Color fundus image.
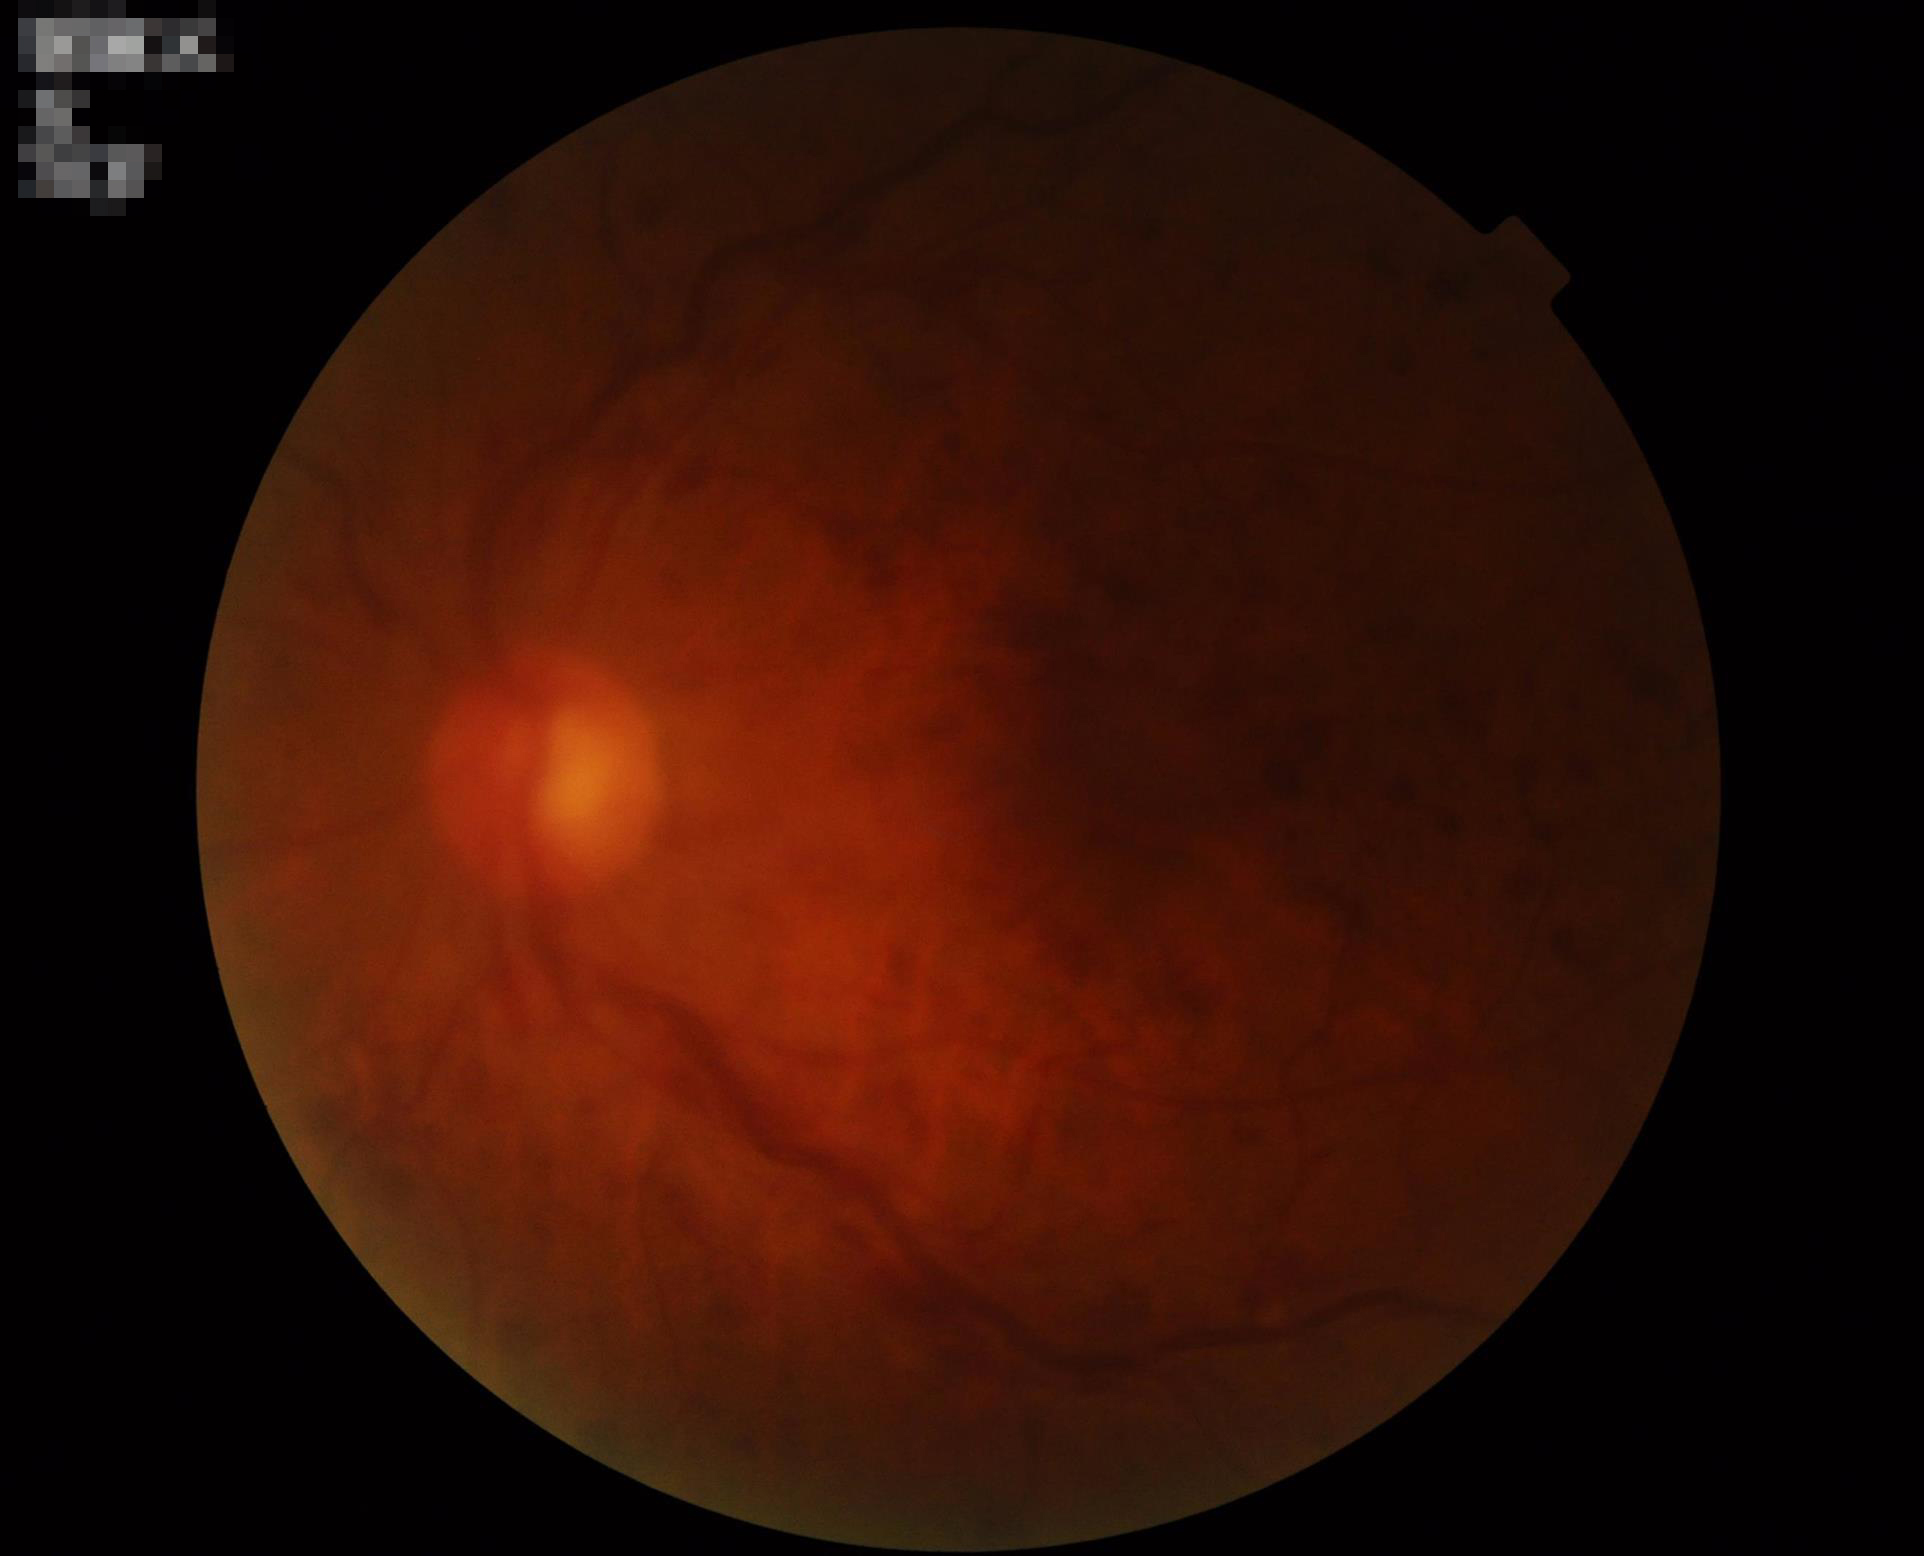

Quality grading: illumination: uneven illumination or color cast | contrast: low, vessels and details hard to distinguish | focus: out of focus, structures indistinct | overall: poor and difficult to use diagnostically.